2048 x 1536 pixels, color fundus image — 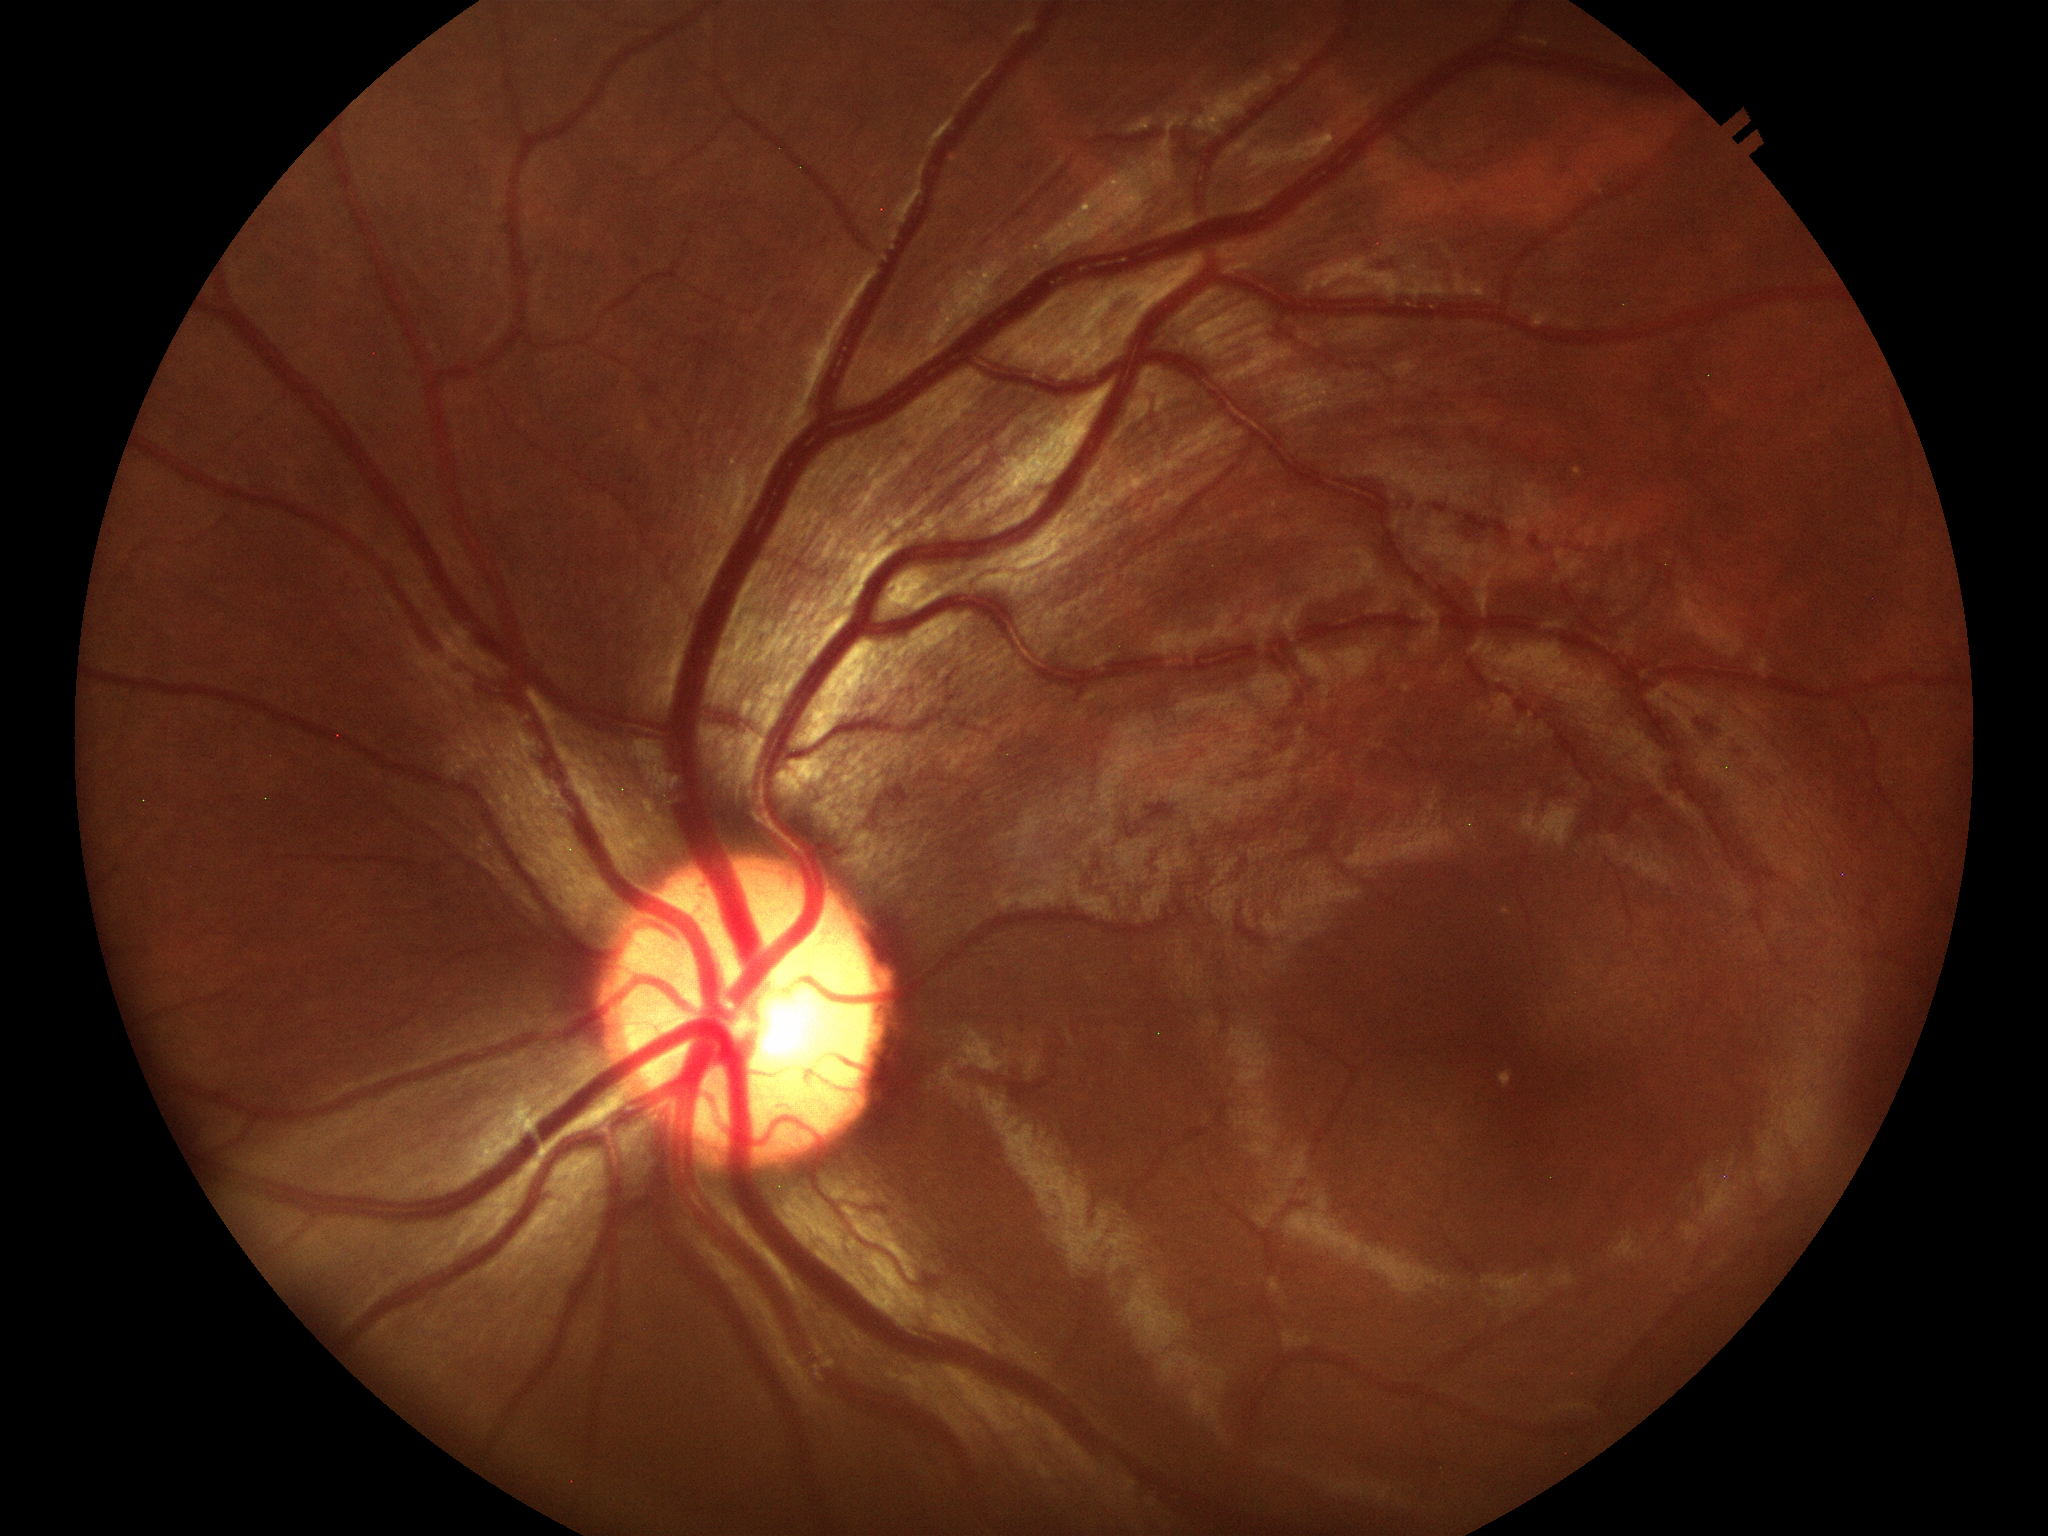 {"glaucoma_decision": "negative (5/5 ophthalmologists in agreement)", "vcdr": "0.50", "hcdr": "0.52", "acdr": "0.26"}